Nonmydriatic fundus photograph; 45° FOV; 848x848; acquired with a NIDEK AFC-230; color fundus photograph — 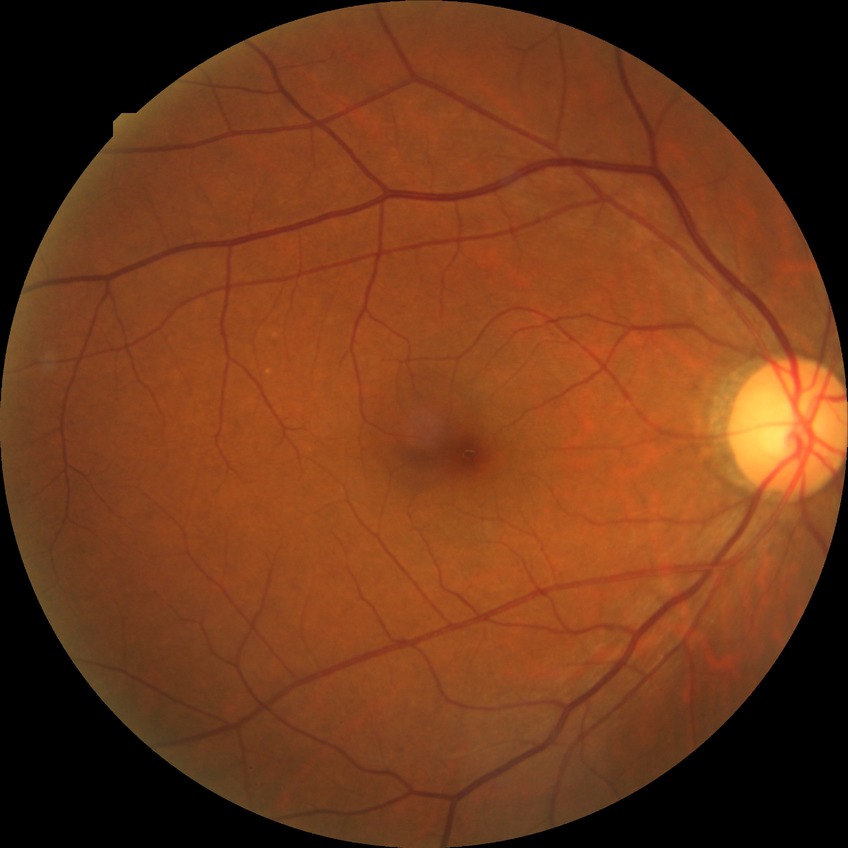
Modified Davis grading: no diabetic retinopathy.